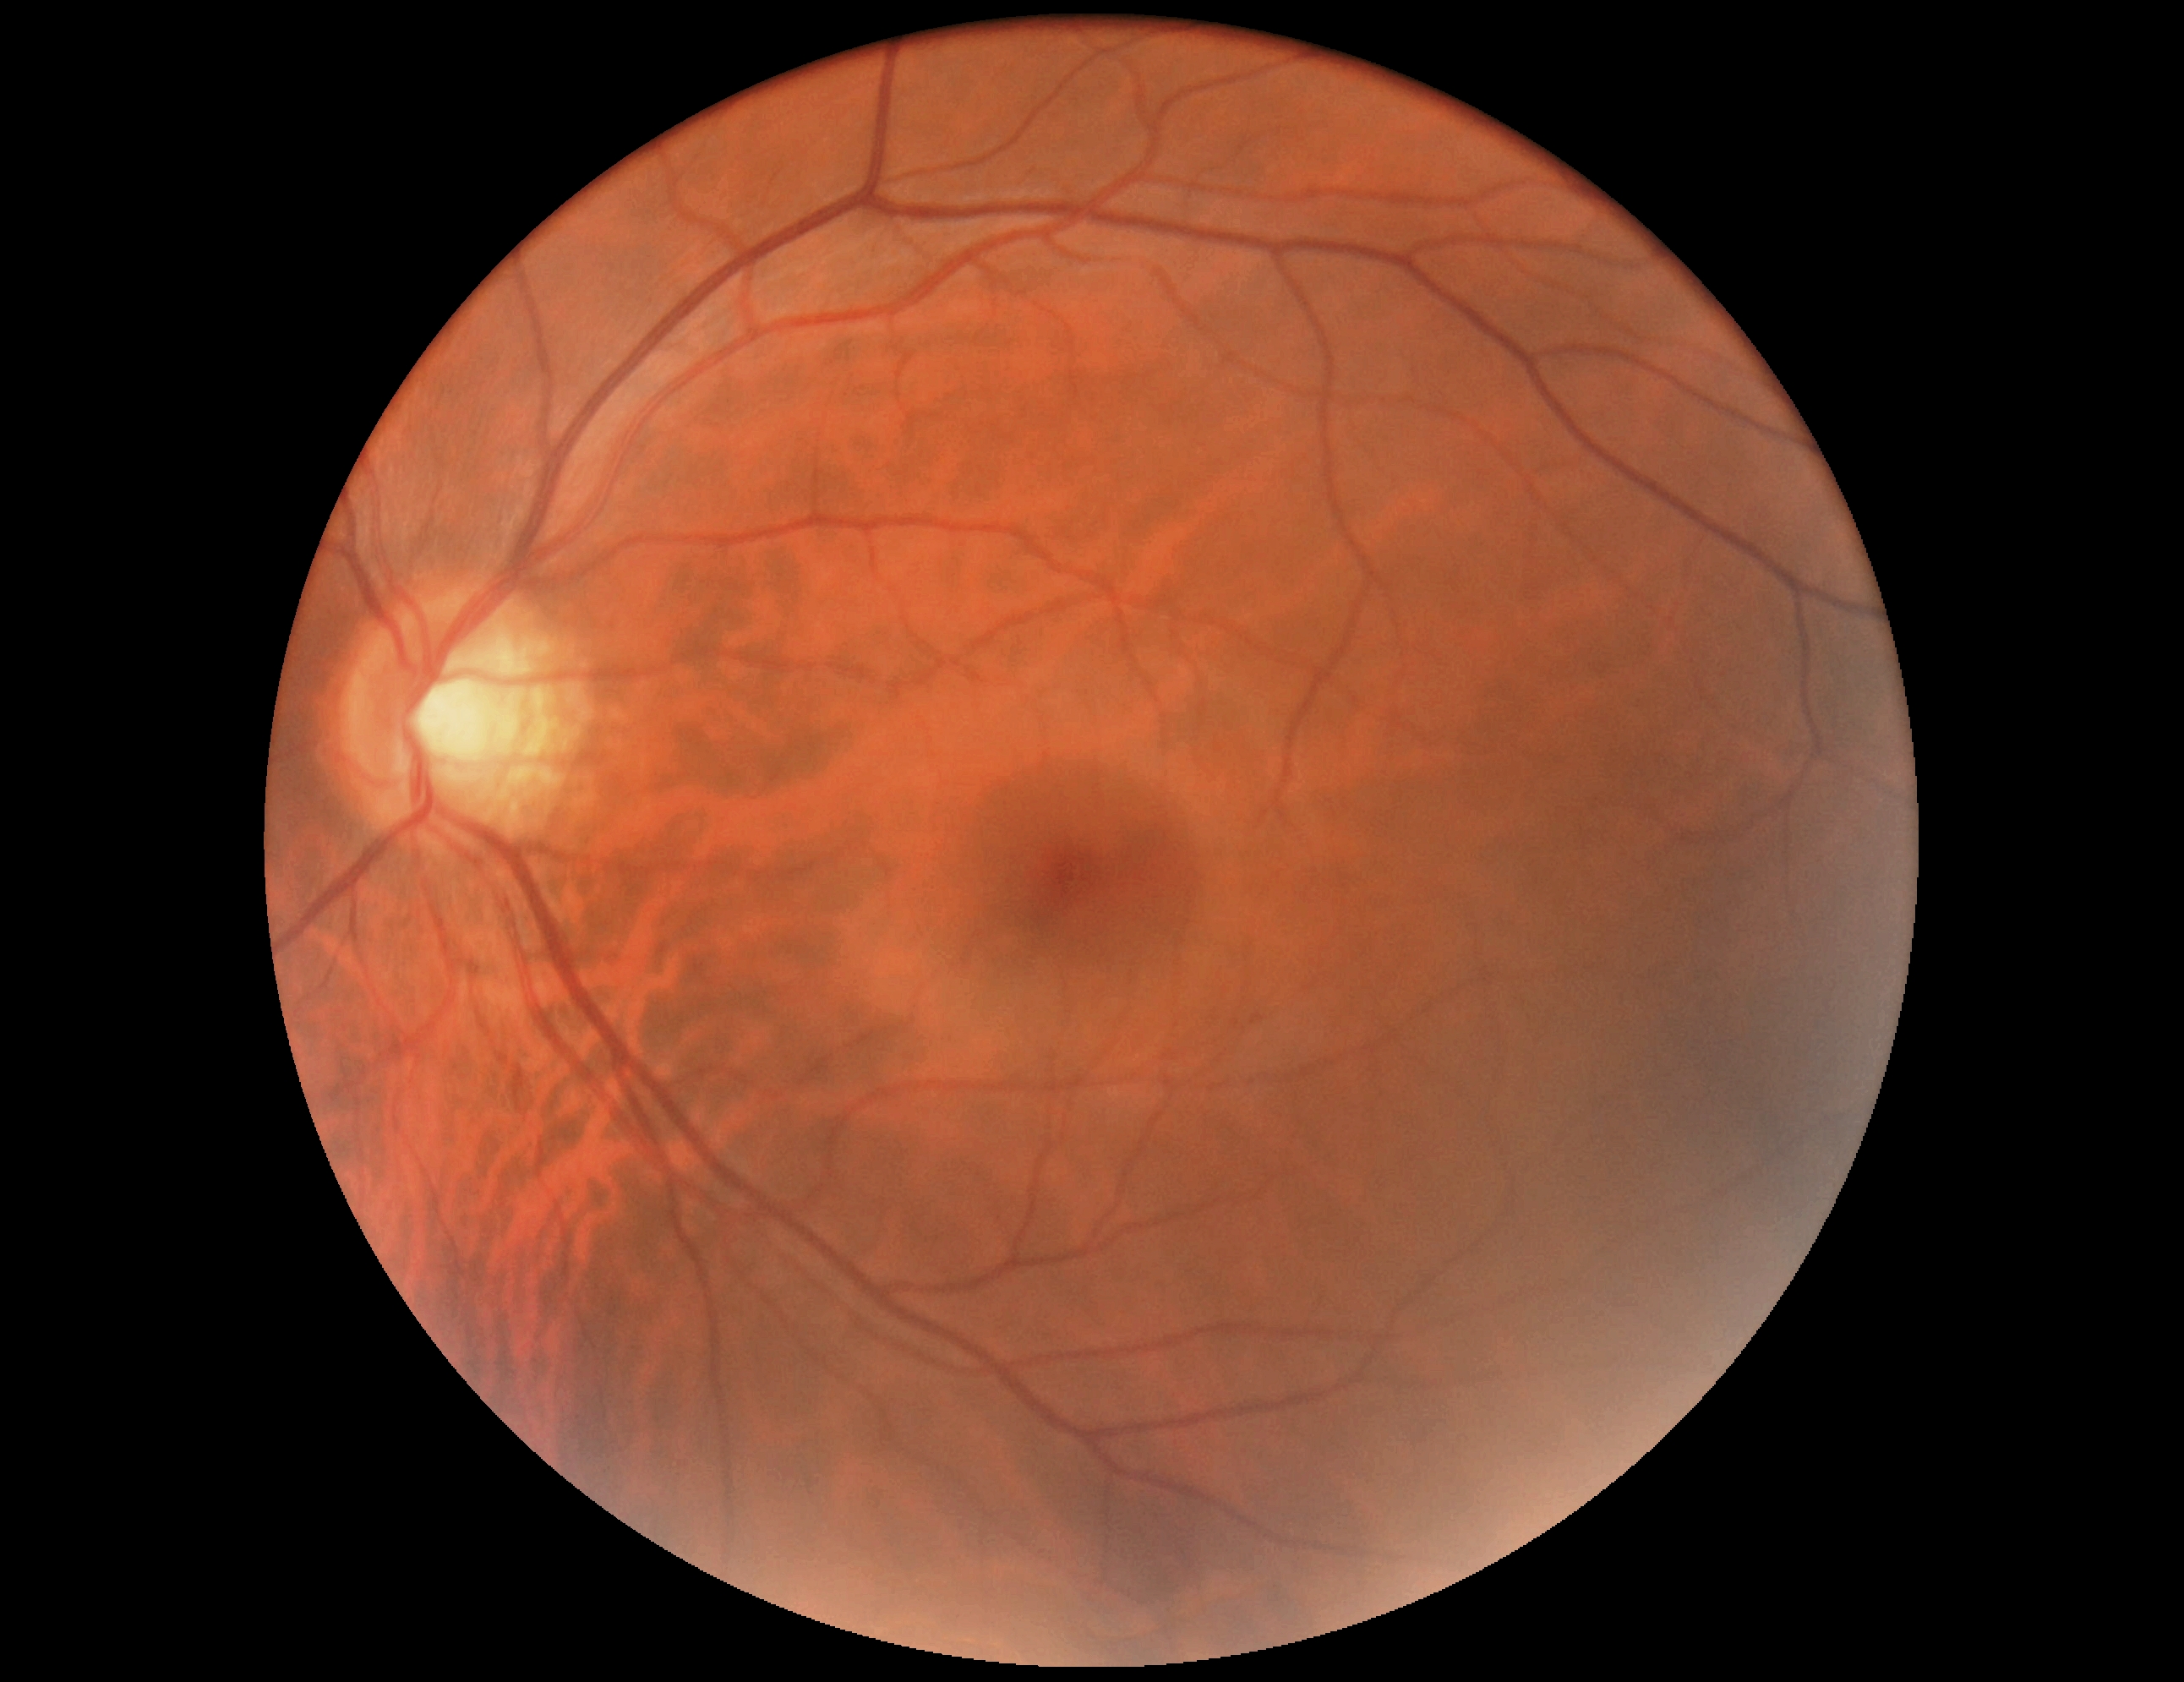
No apparent diabetic retinopathy.
Diabetic retinopathy (DR) is grade 0 (no apparent retinopathy).